130° field of view (Clarity RetCam 3); pediatric retinal photograph (wide-field): 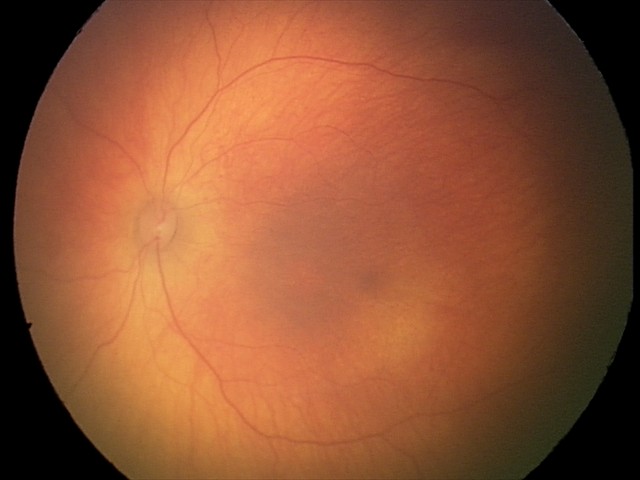 No retinal pathology identified on screening.